Fundus photo; image size 2352x1568; FOV: 45 degrees:
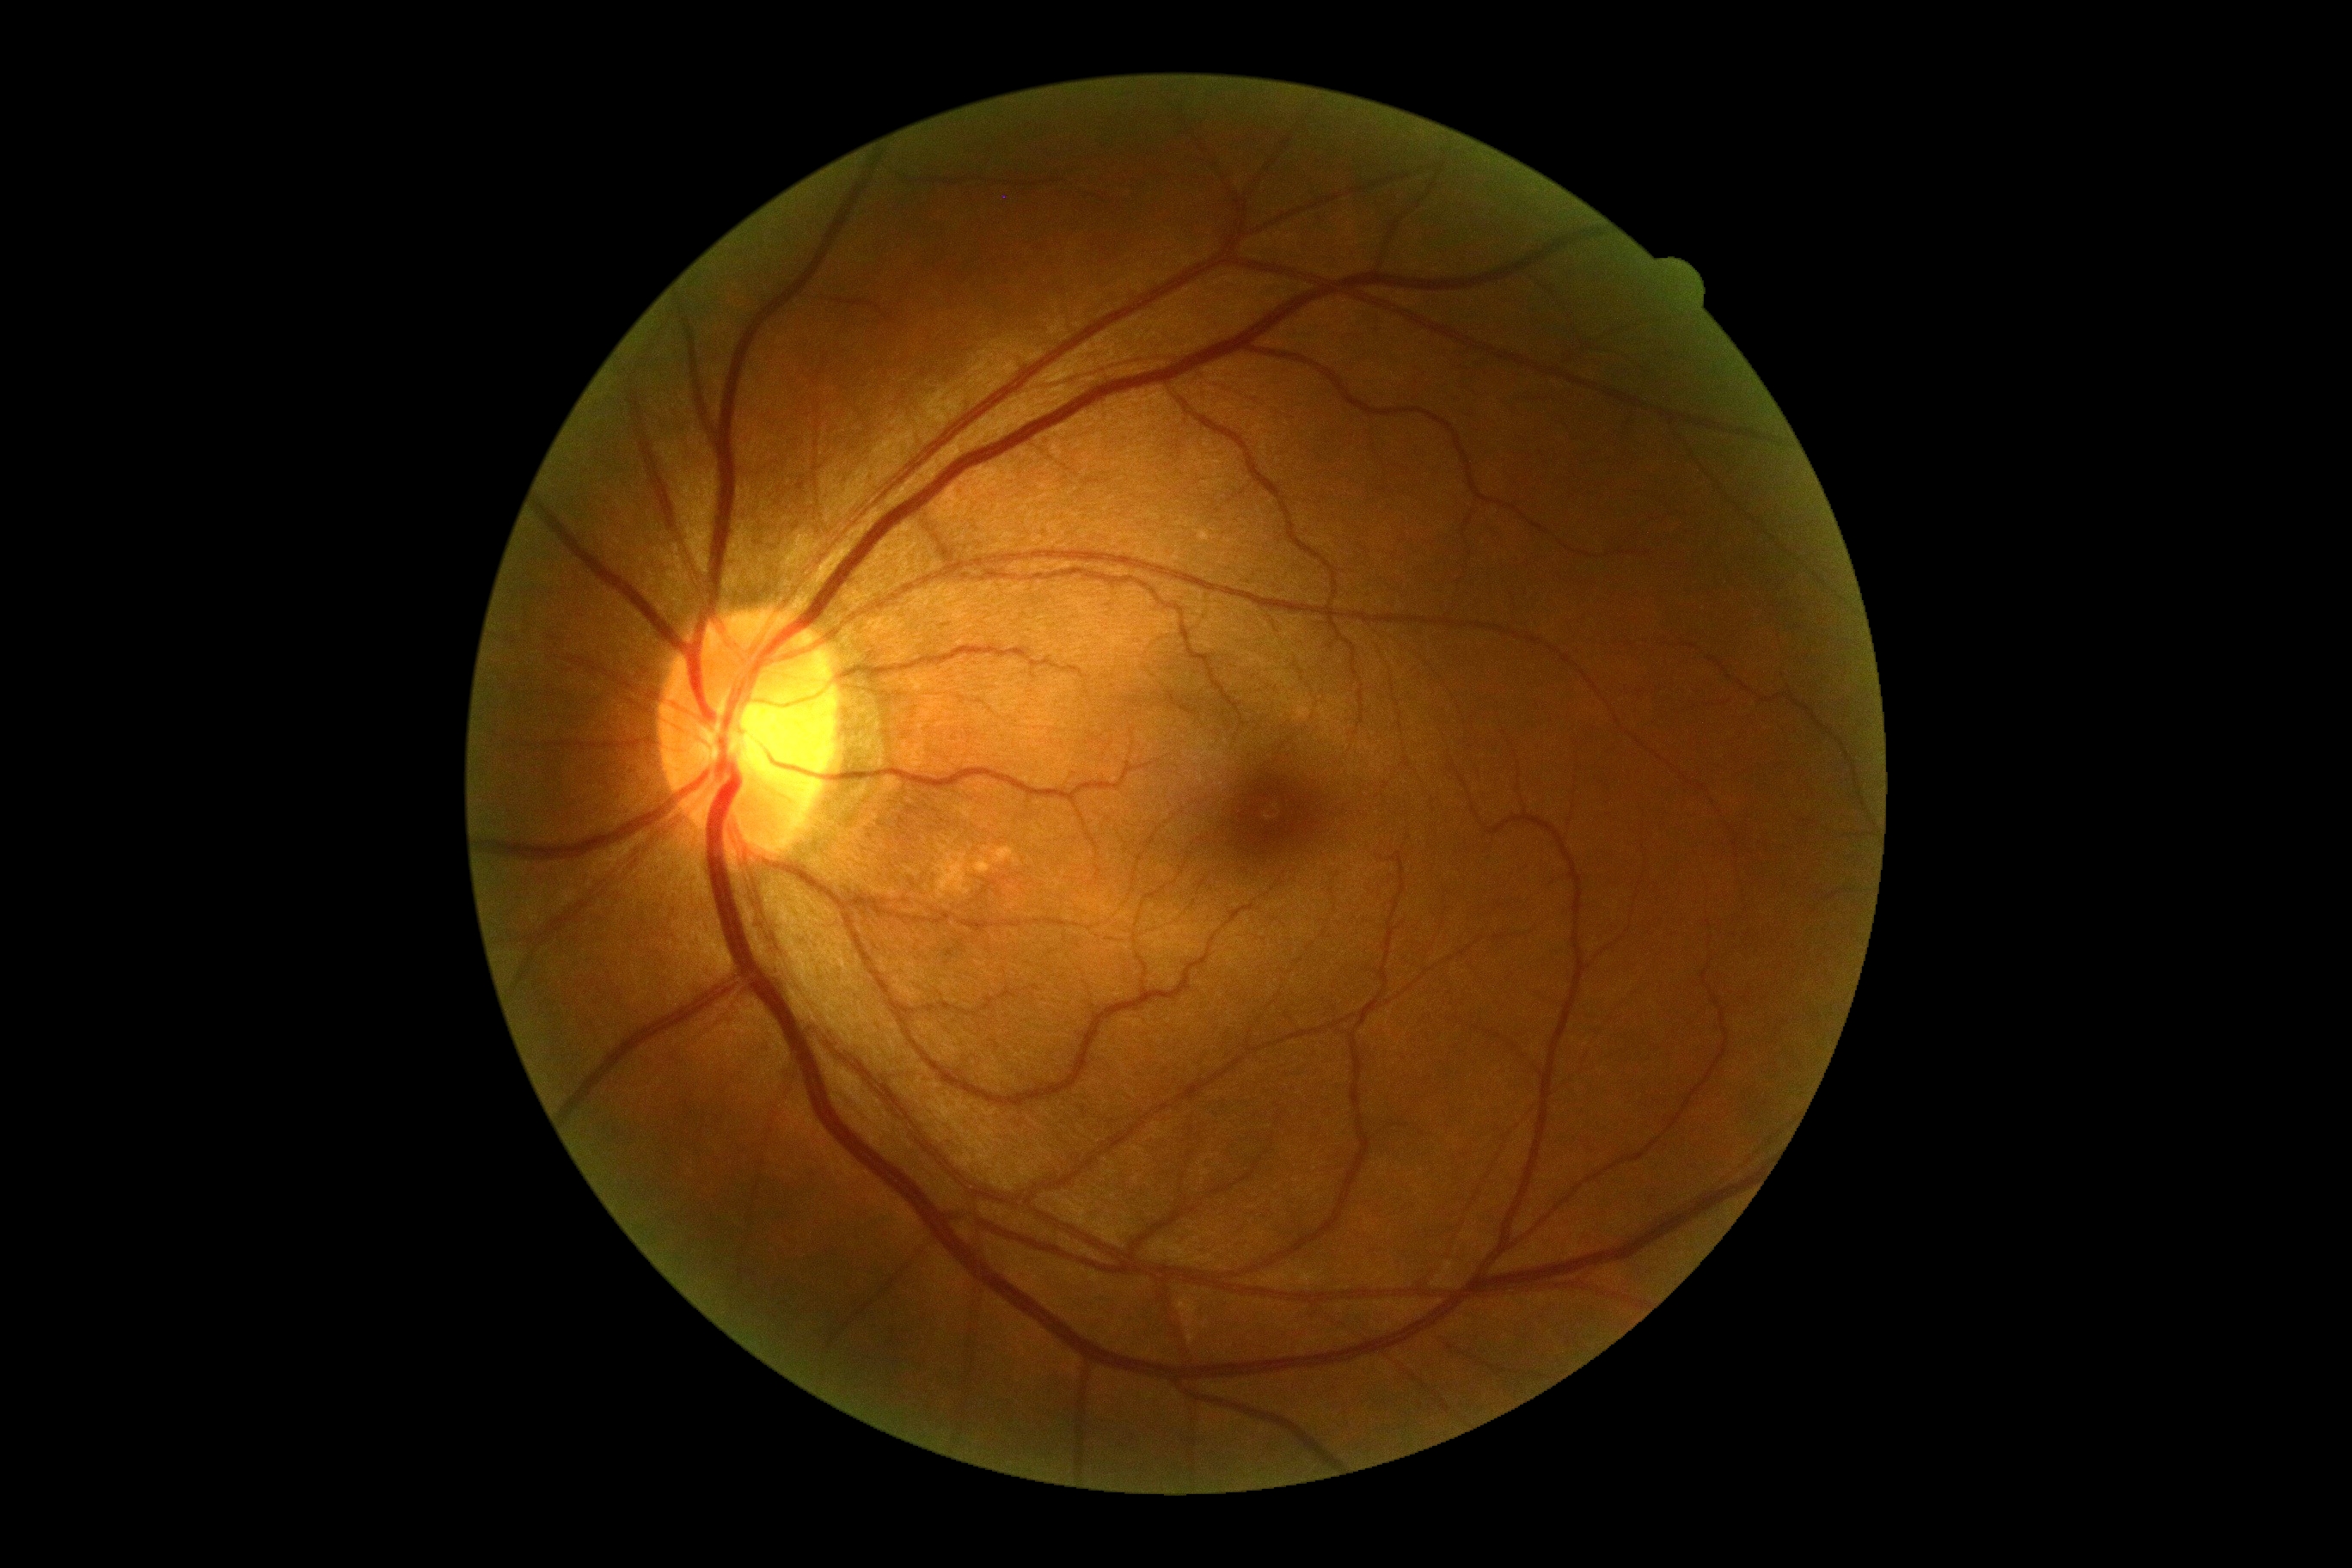 DR severity: 0/4.